NIDEK AFC-230; CFP; 45° field of view; 848x848; graded on the modified Davis scale.
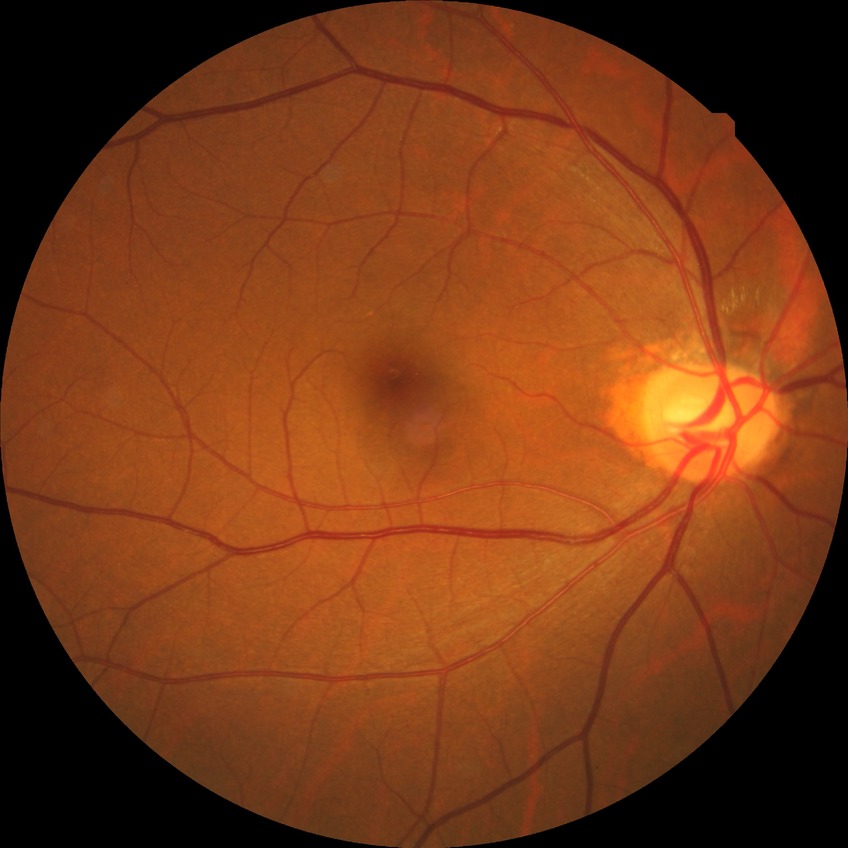 Diabetic retinopathy grade: no diabetic retinopathy.